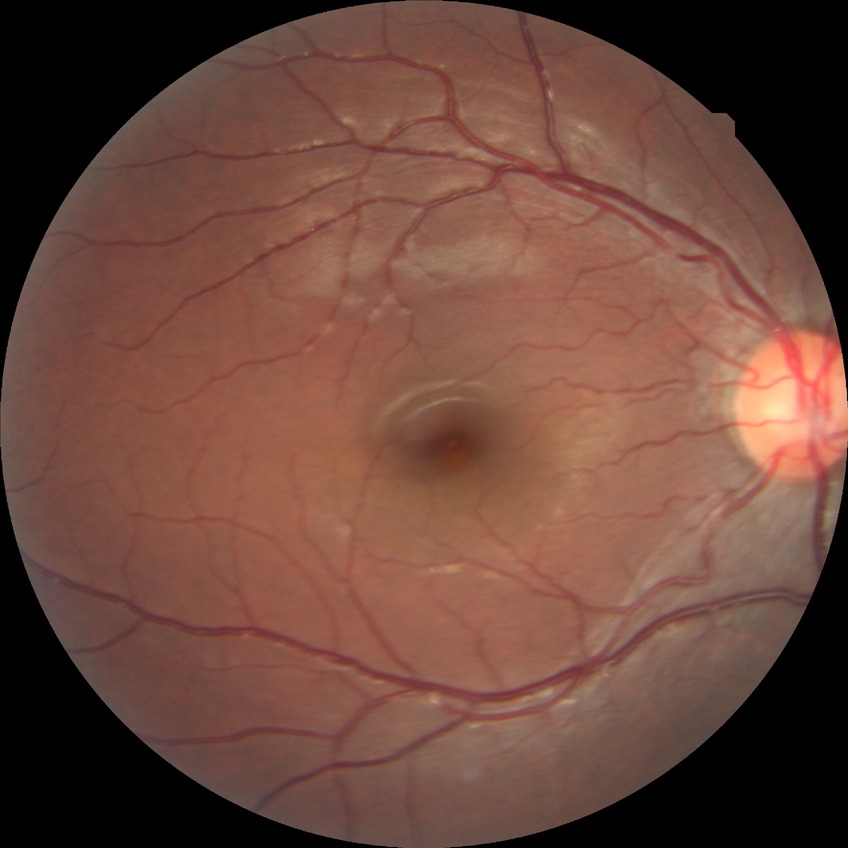

Davis DR grade is NDR.